CFP. NIDEK AFC-230. Nonmydriatic. 45 degree fundus photograph. 848 x 848 pixels: 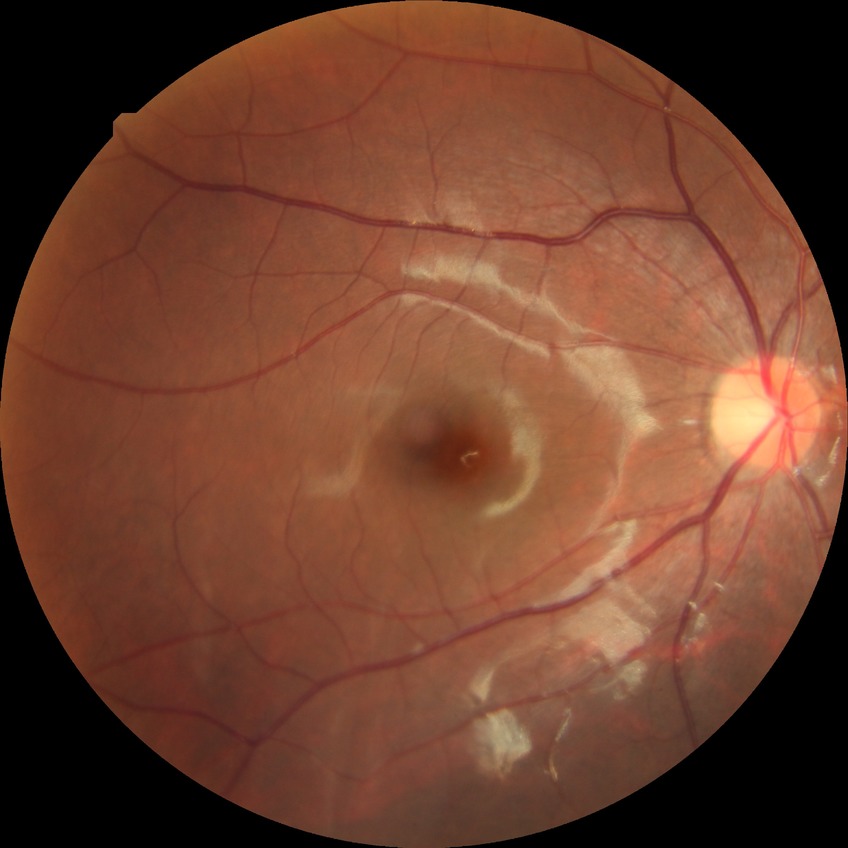
{"davis_grade": "no diabetic retinopathy"}